Infant wide-field fundus photograph — 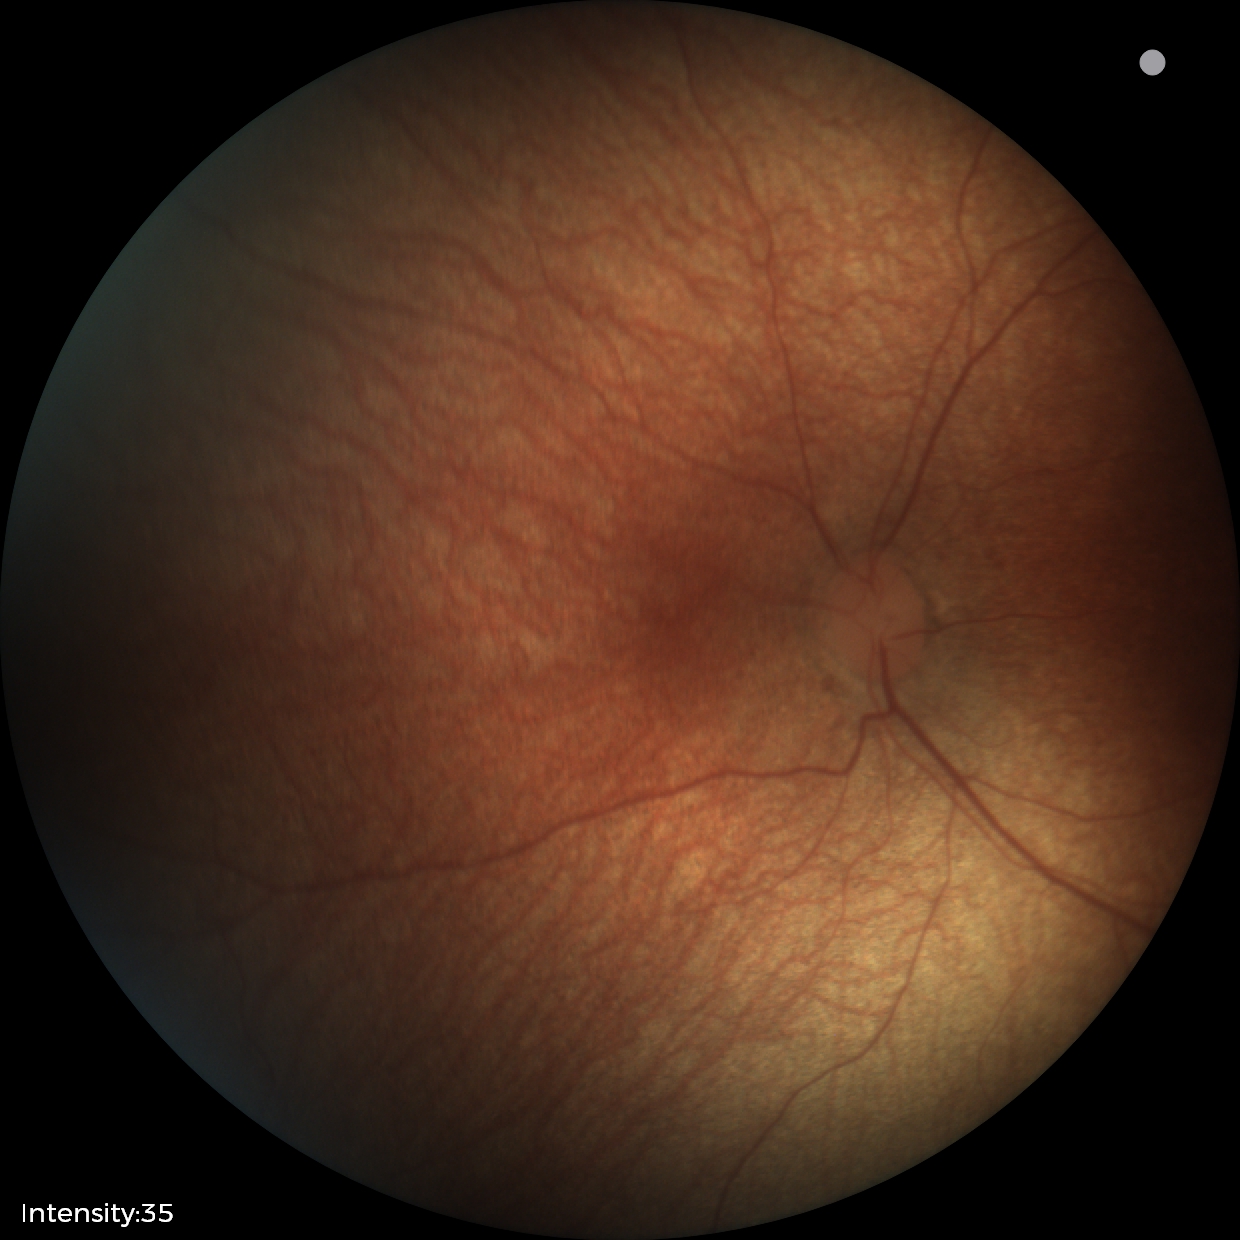

Screening examination with no abnormal retinal findings.